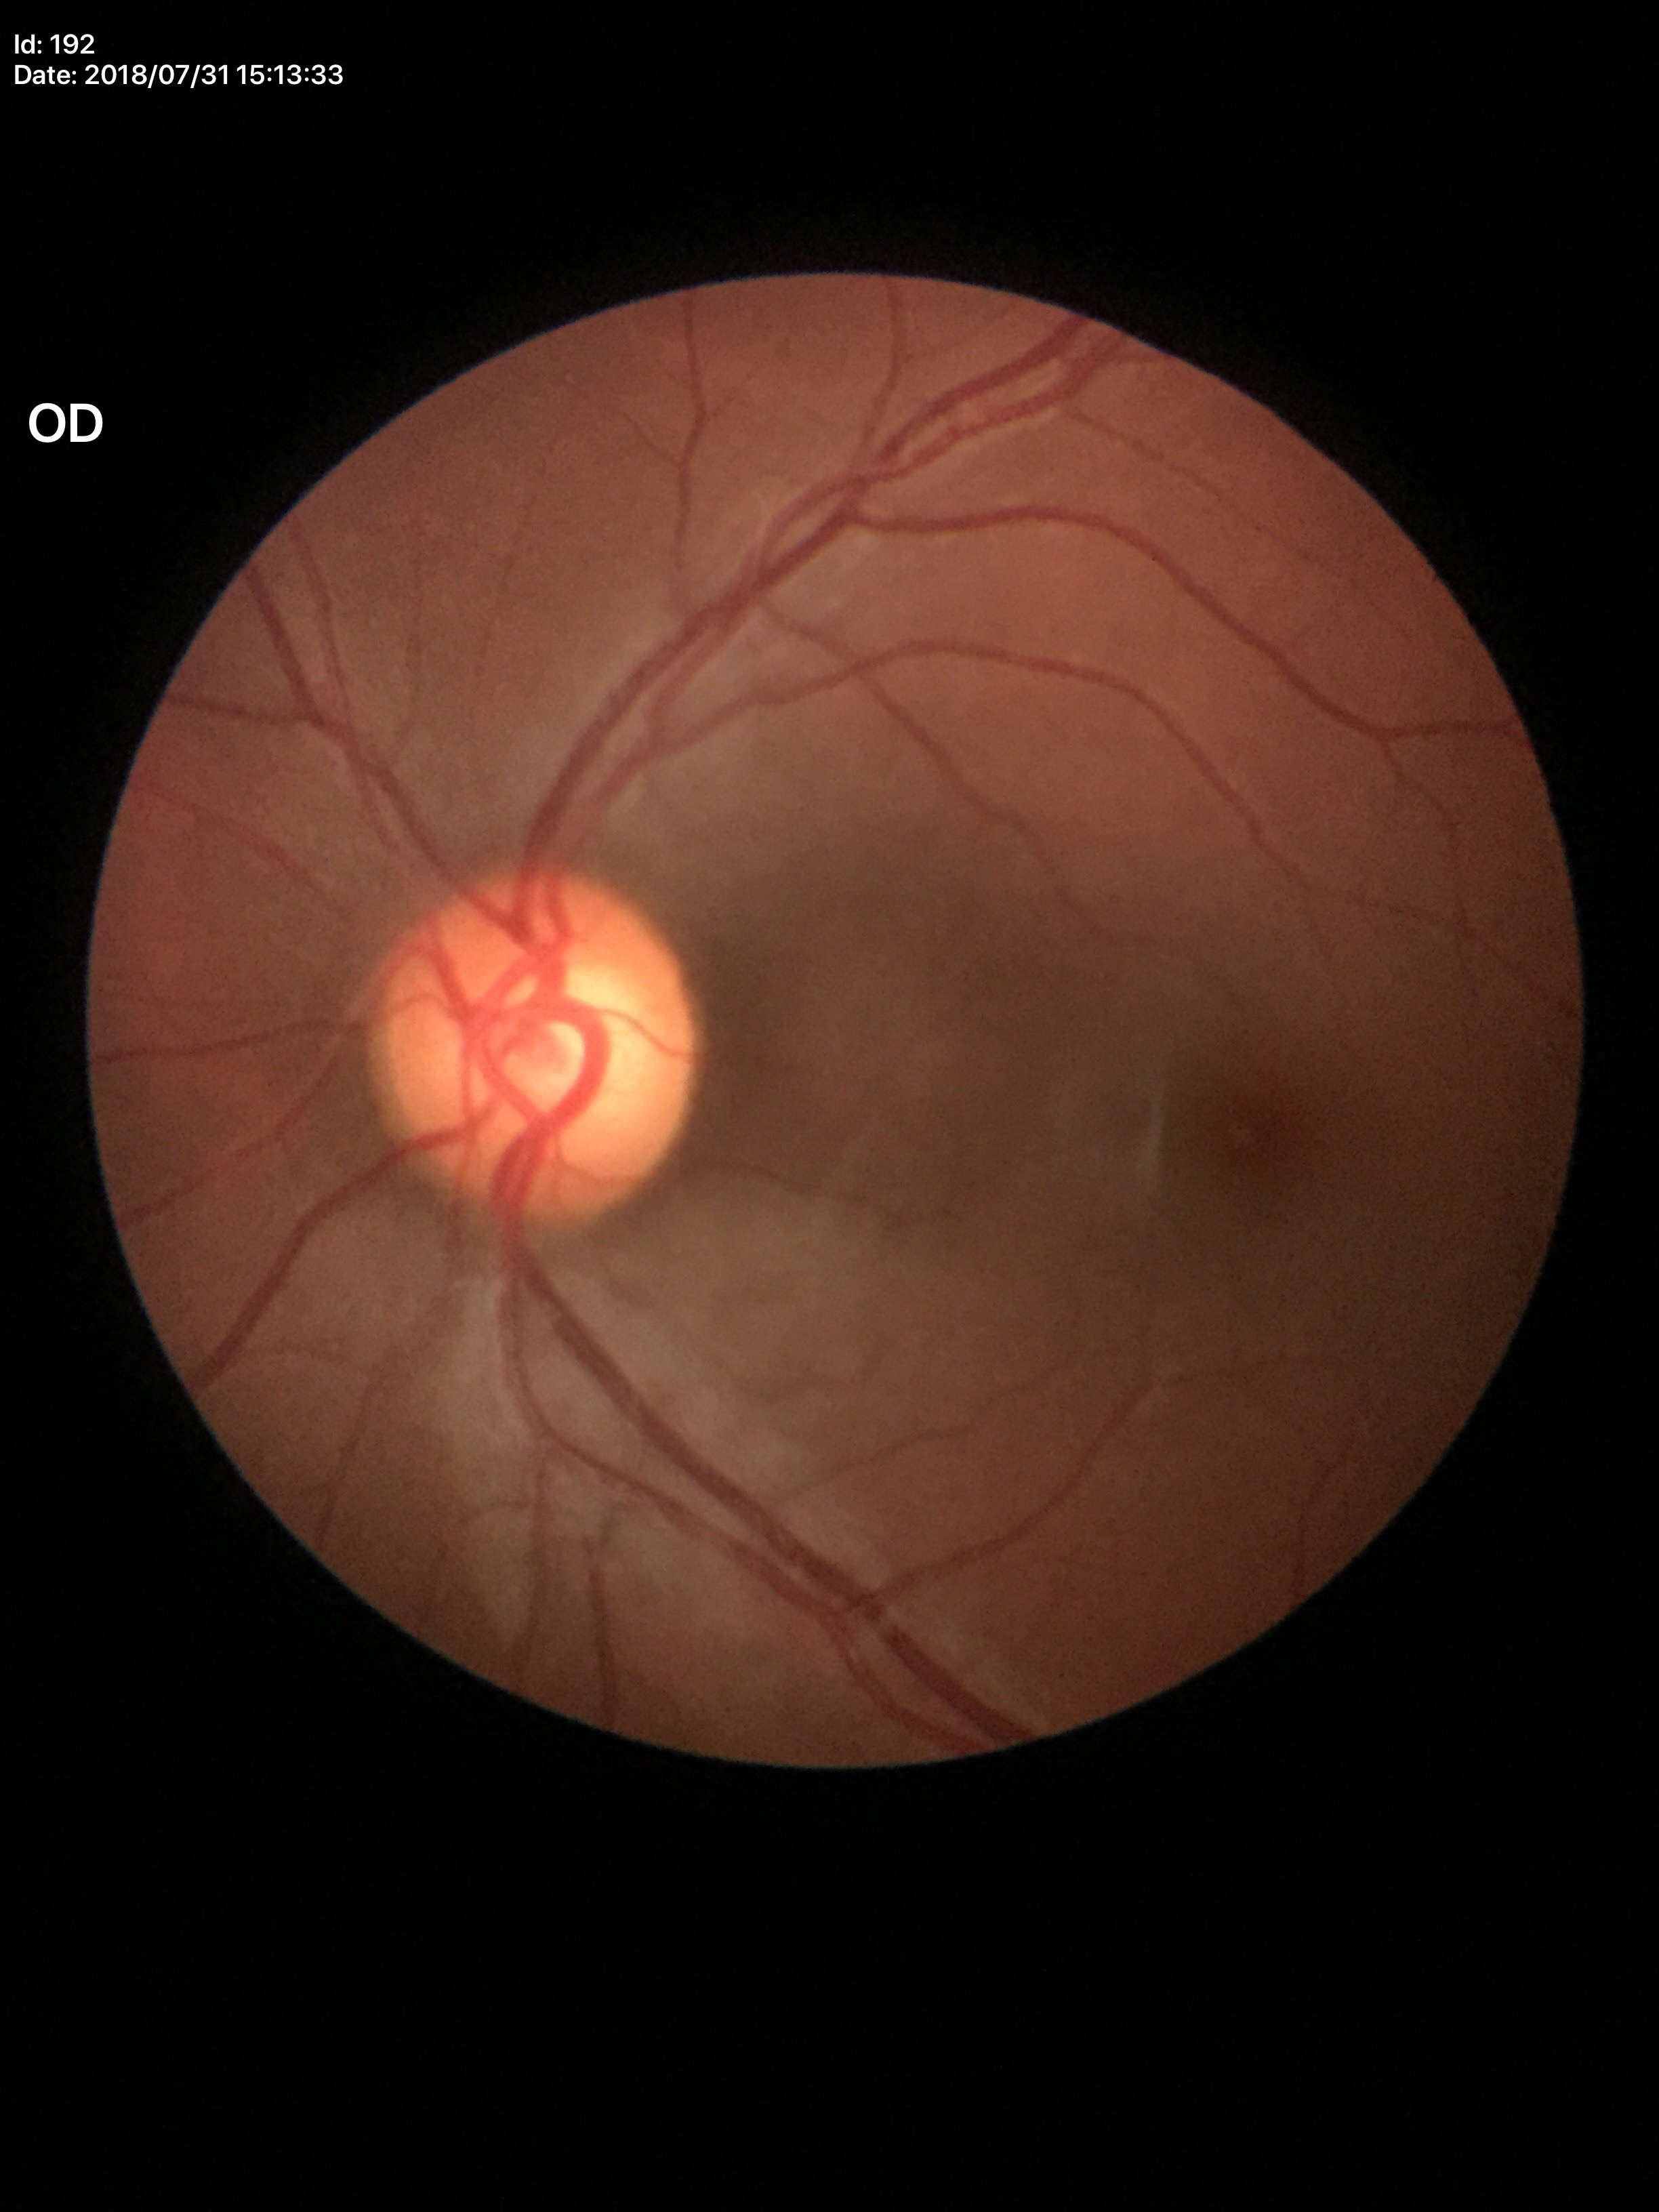
Vertical cup-to-disc ratio (VCDR) of 0.60.
Horizontal cup-to-disc ratio (HCDR): 0.63.
Glaucoma screening impression: suspicious (3 of 5 graders flagged glaucoma suspect).